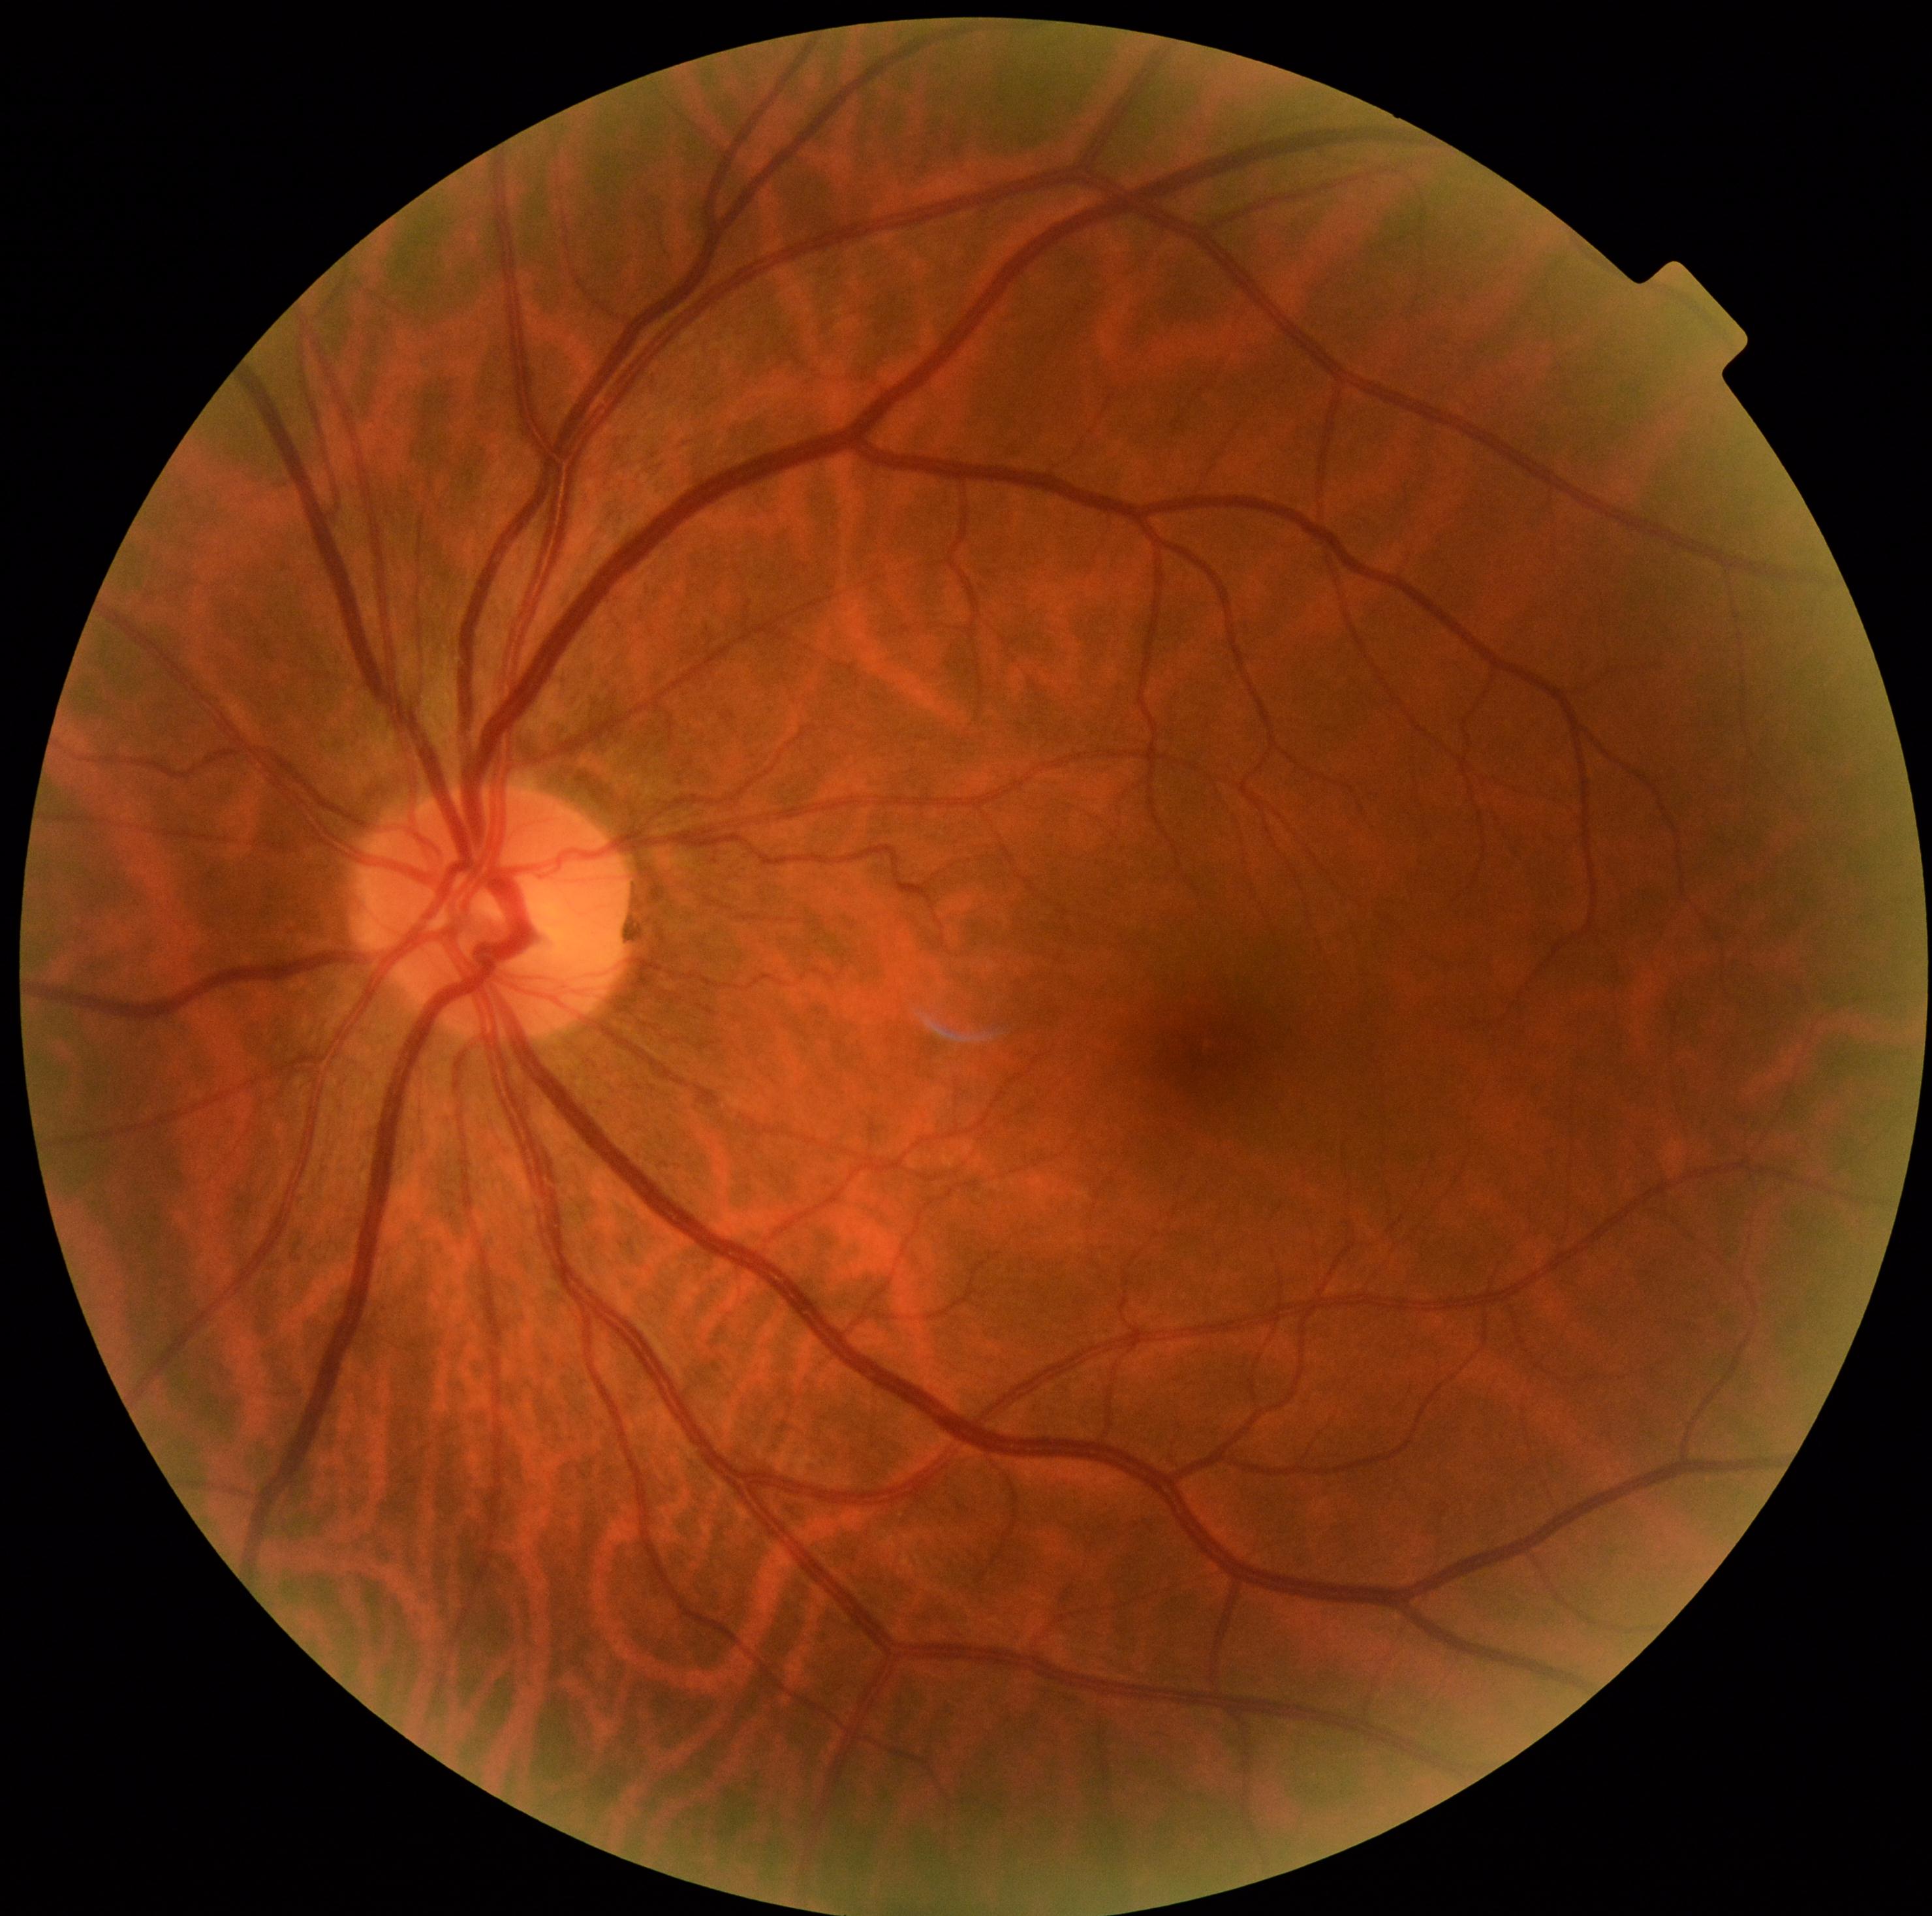 {
  "dr_grade": "no apparent diabetic retinopathy (grade 0)",
  "dr_impression": "no signs of DR"
}